Camera: Topcon TRC-50DX.
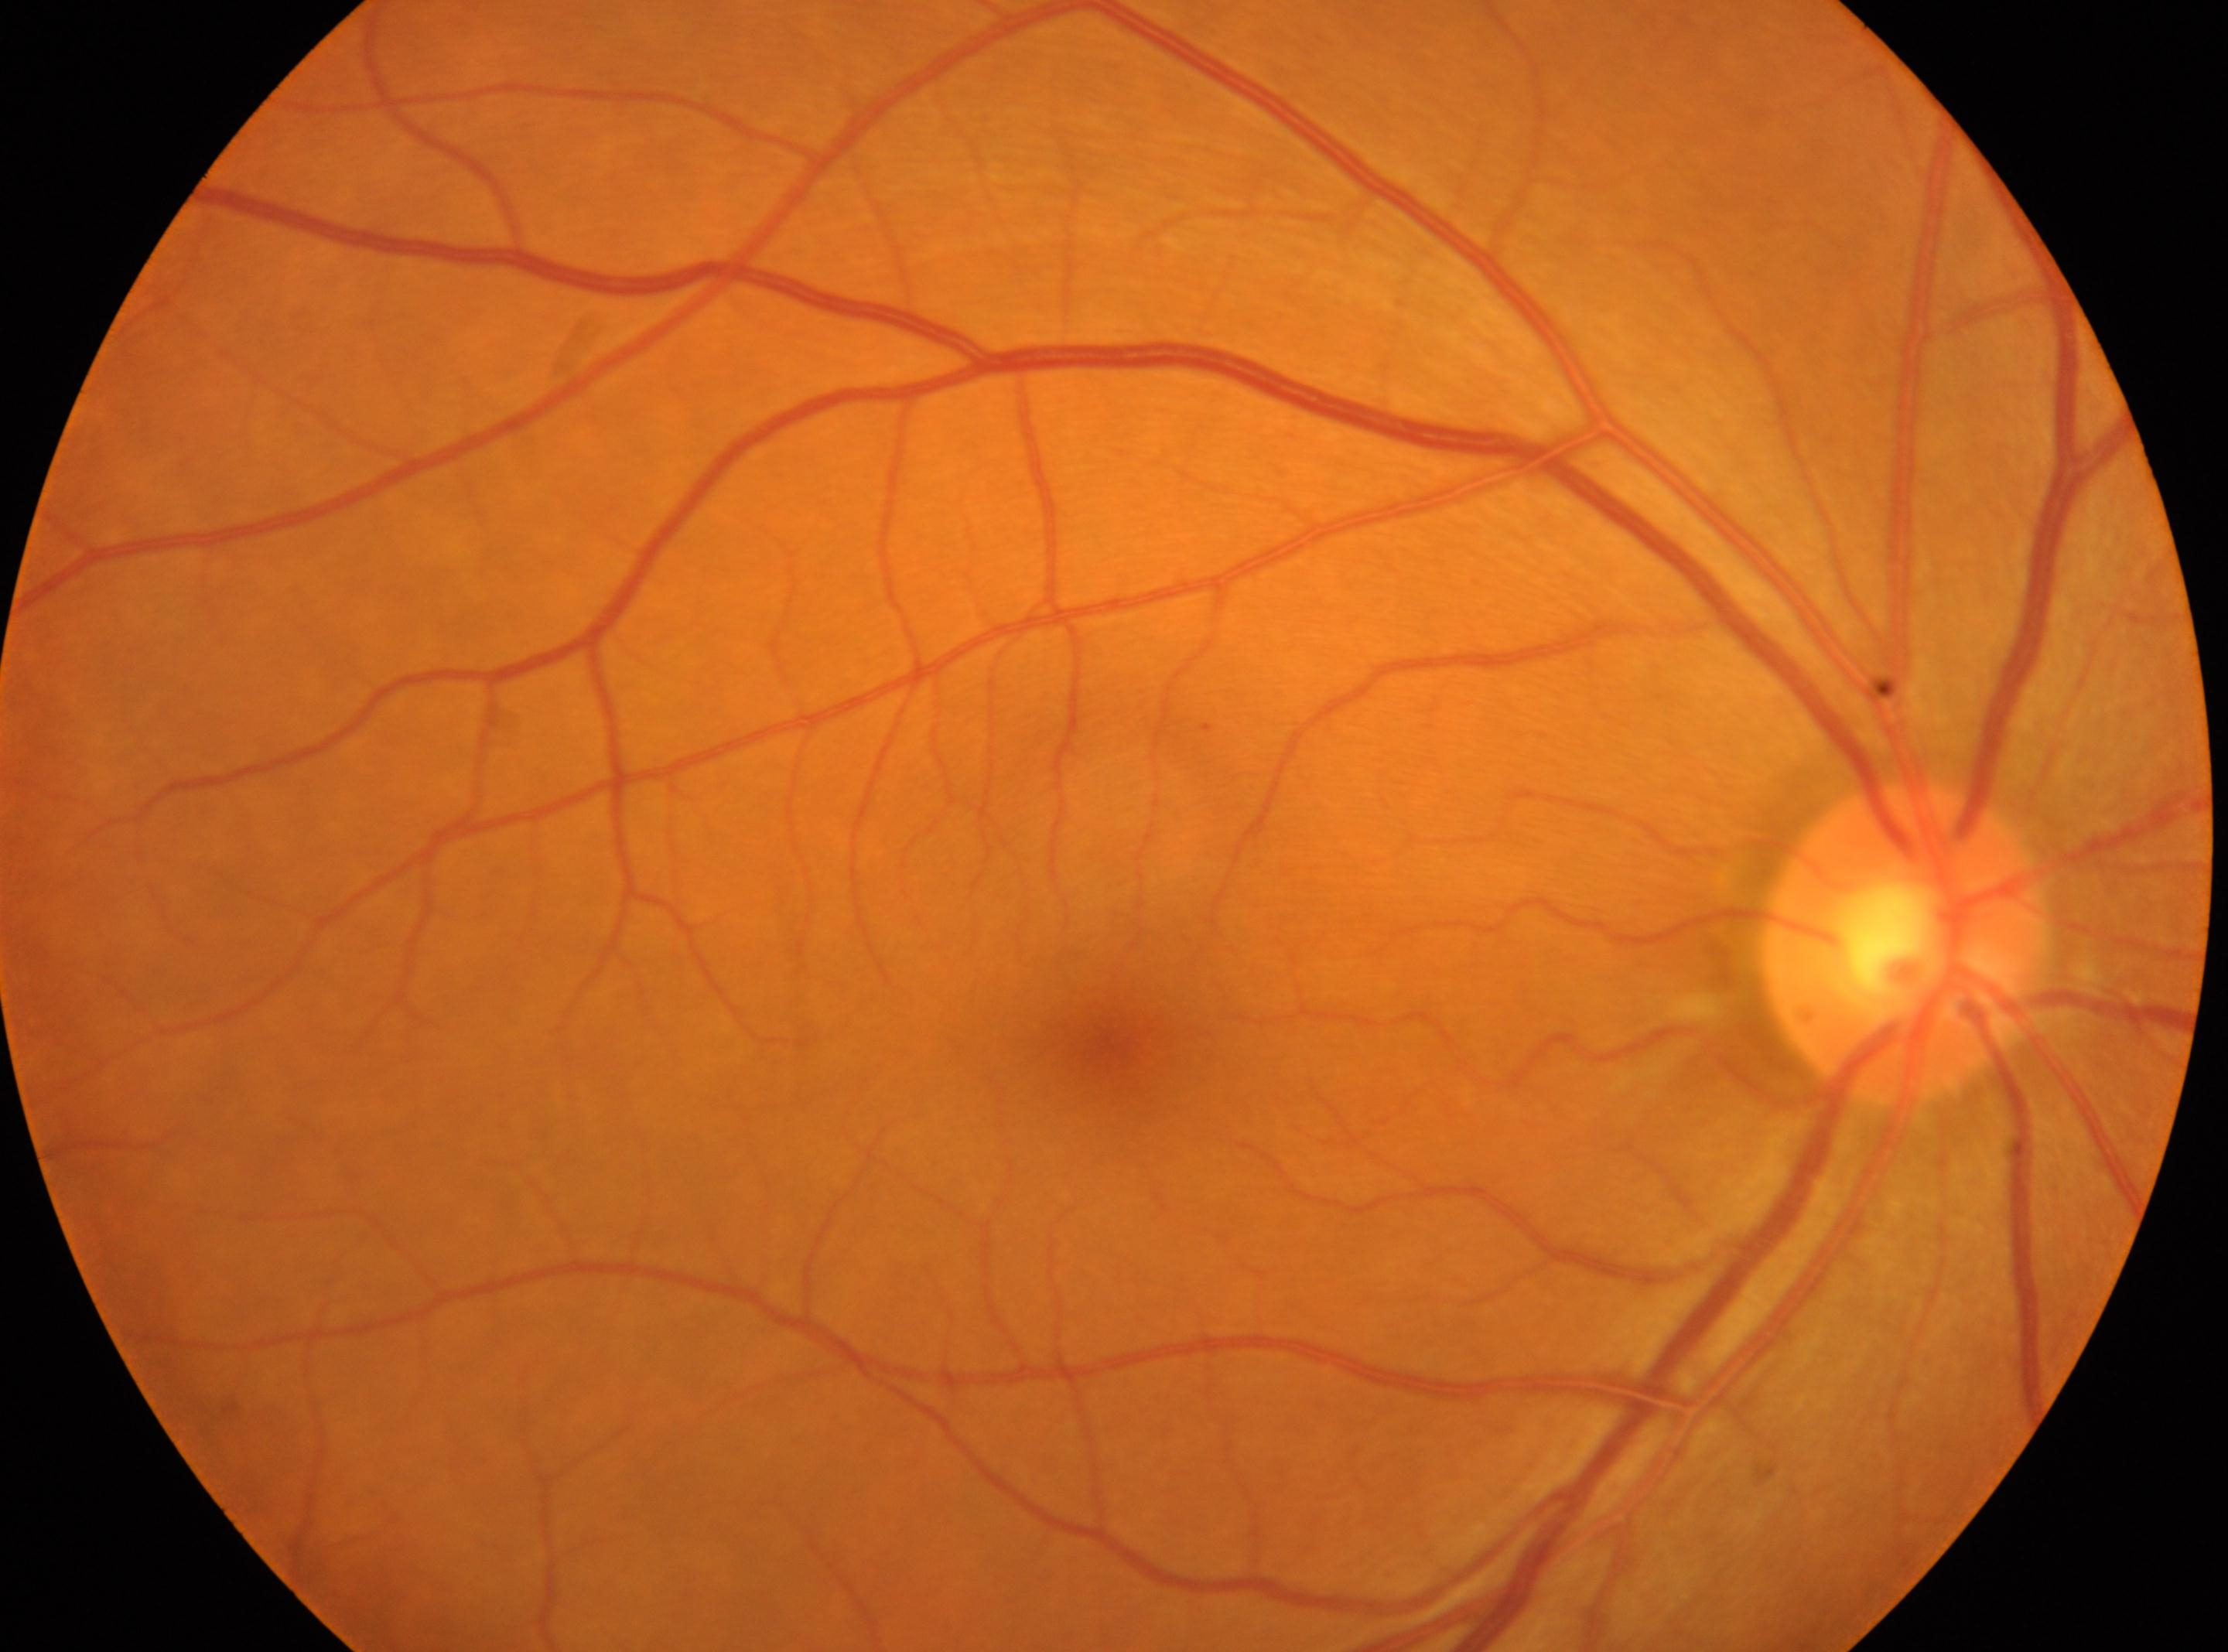 Fovea centralis: [1116, 1044].
DR: 1.
The disc center is at [1902, 942].
Eye: oculus dexter.